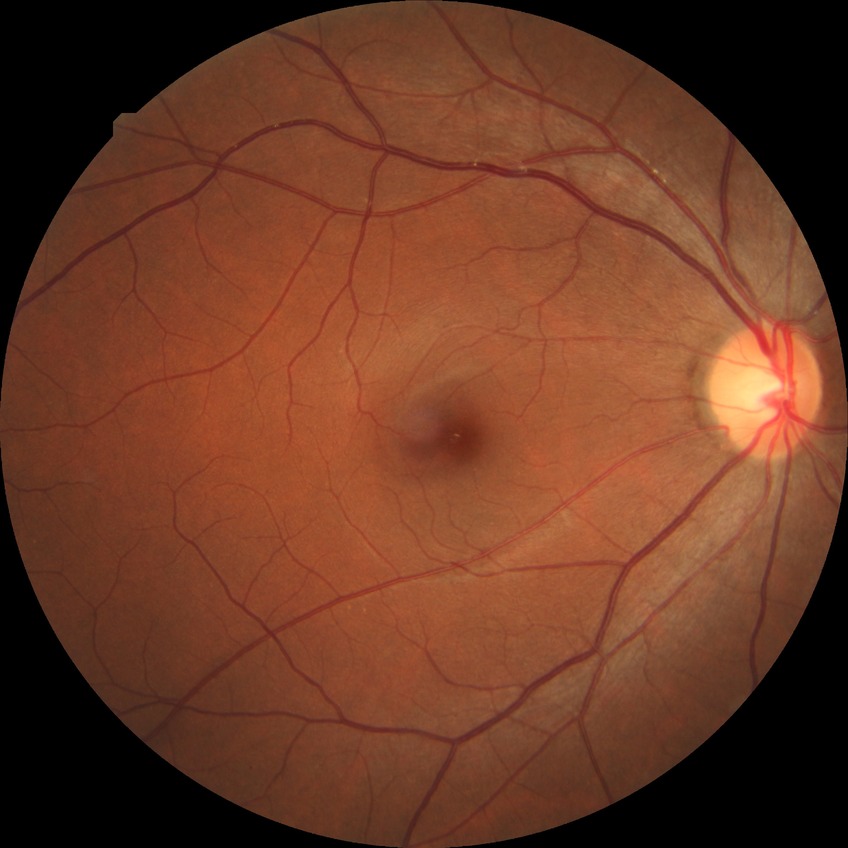

diabetic retinopathy stage = no diabetic retinopathy.